DR severity per modified Davis staging: 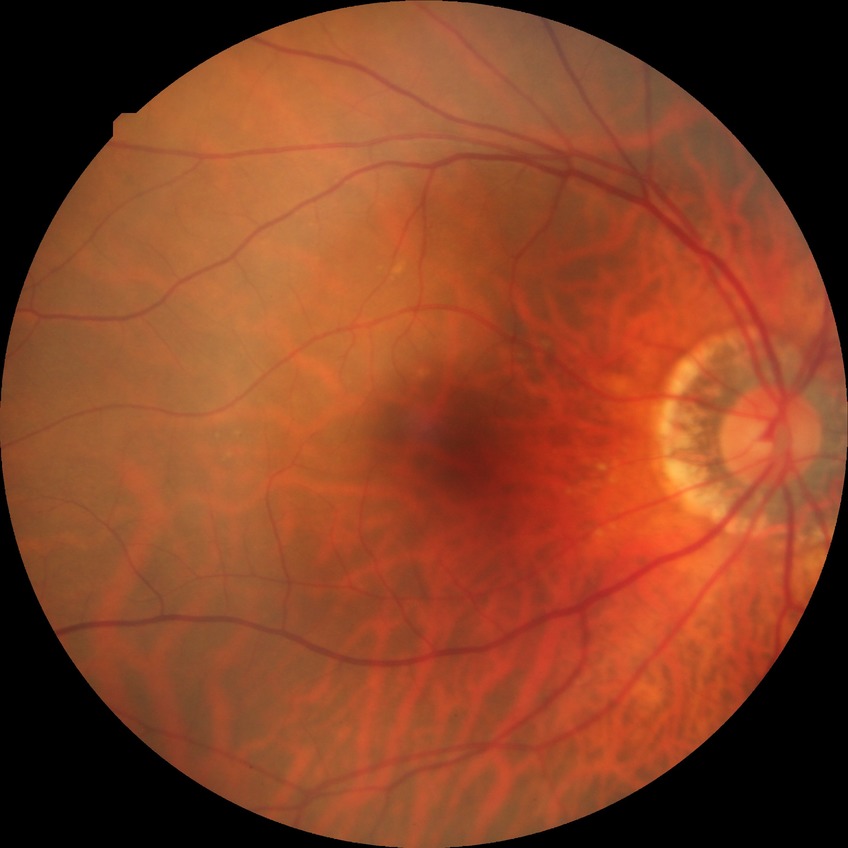   davis_grade: no diabetic retinopathy